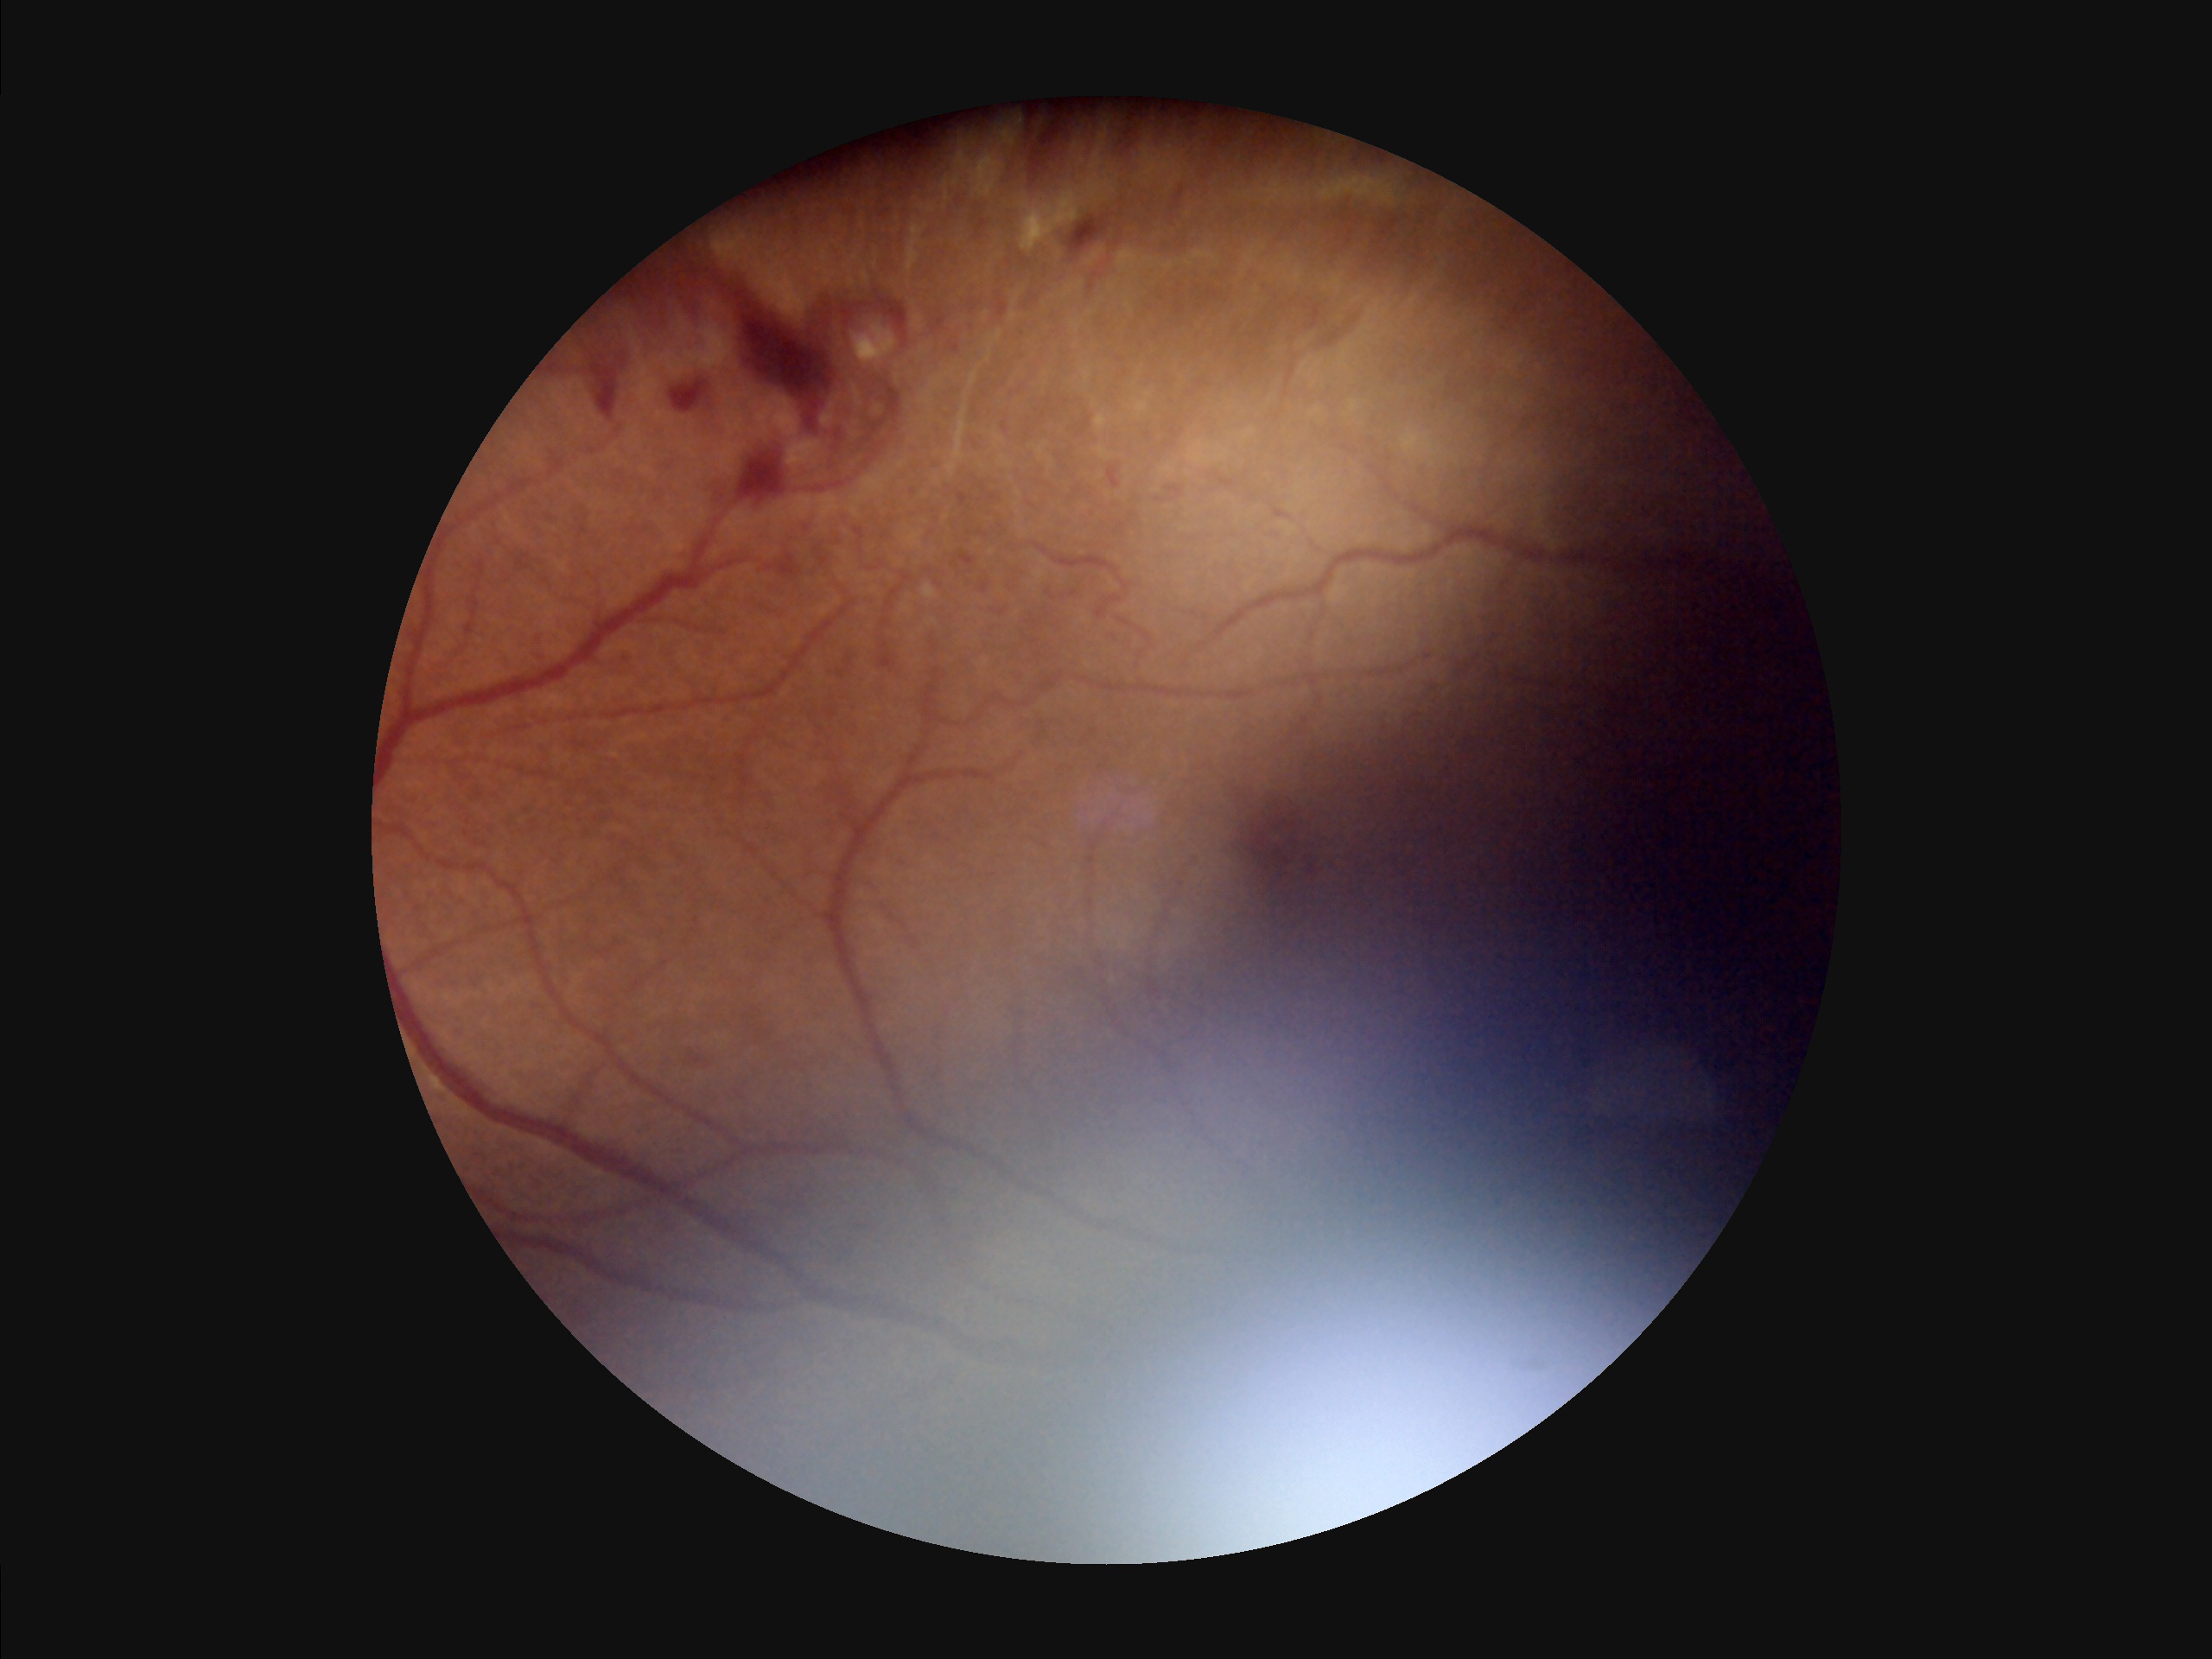

Quality assessment: overall: inadequate for clinical interpretation | contrast: vessels and details readily distinguishable | clarity: reduced sharpness with visible blur | illumination/color: over- or under-exposed.